848x848; no pharmacologic dilation.
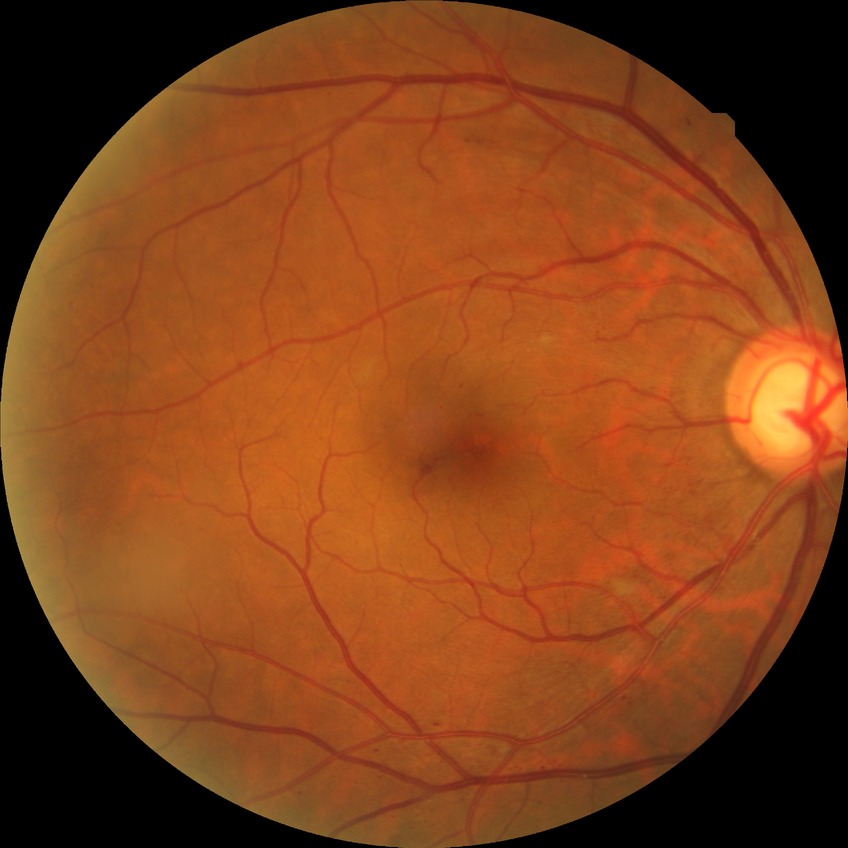 Disease class: non-proliferative diabetic retinopathy. Diabetic retinopathy grade is simple diabetic retinopathy.